Diabetic retinopathy graded by the modified Davis classification · 45 degree fundus photograph: 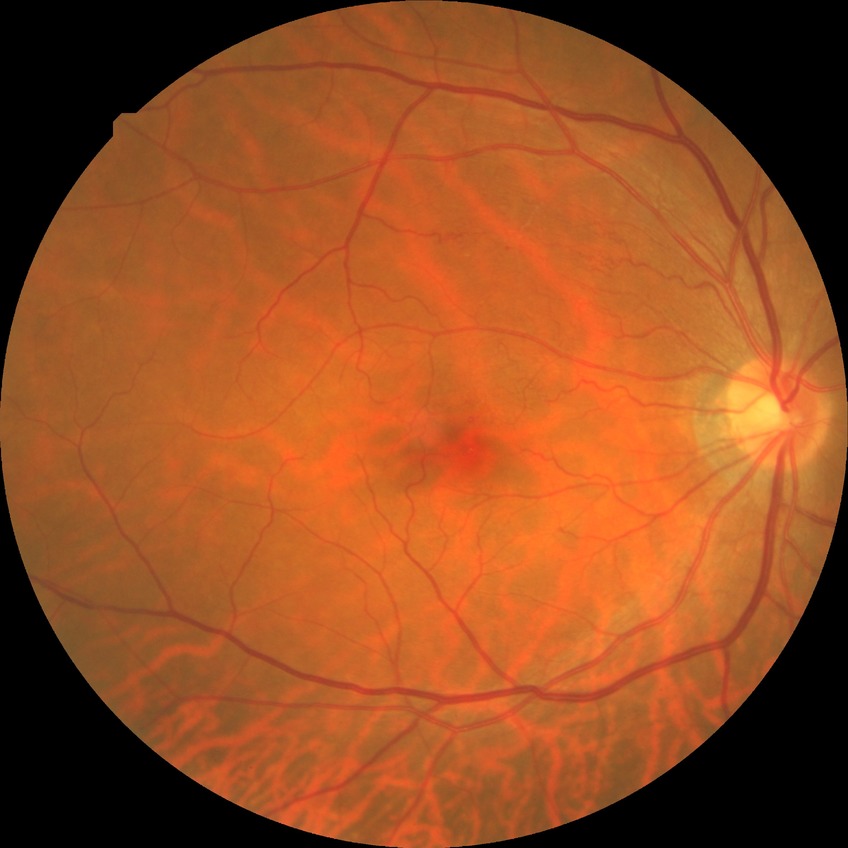

No apparent diabetic retinopathy. Davis grade is NDR.